RetCam wide-field infant fundus image · Clarity RetCam 3, 130° FOV: 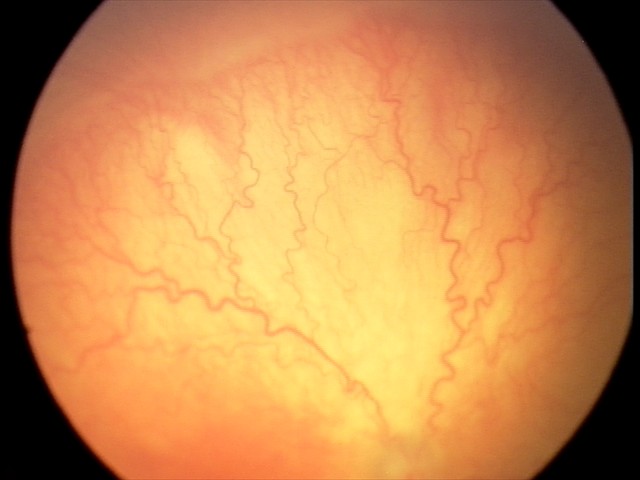

Plus disease: present | screening diagnosis: aggressive ROP (A-ROP).